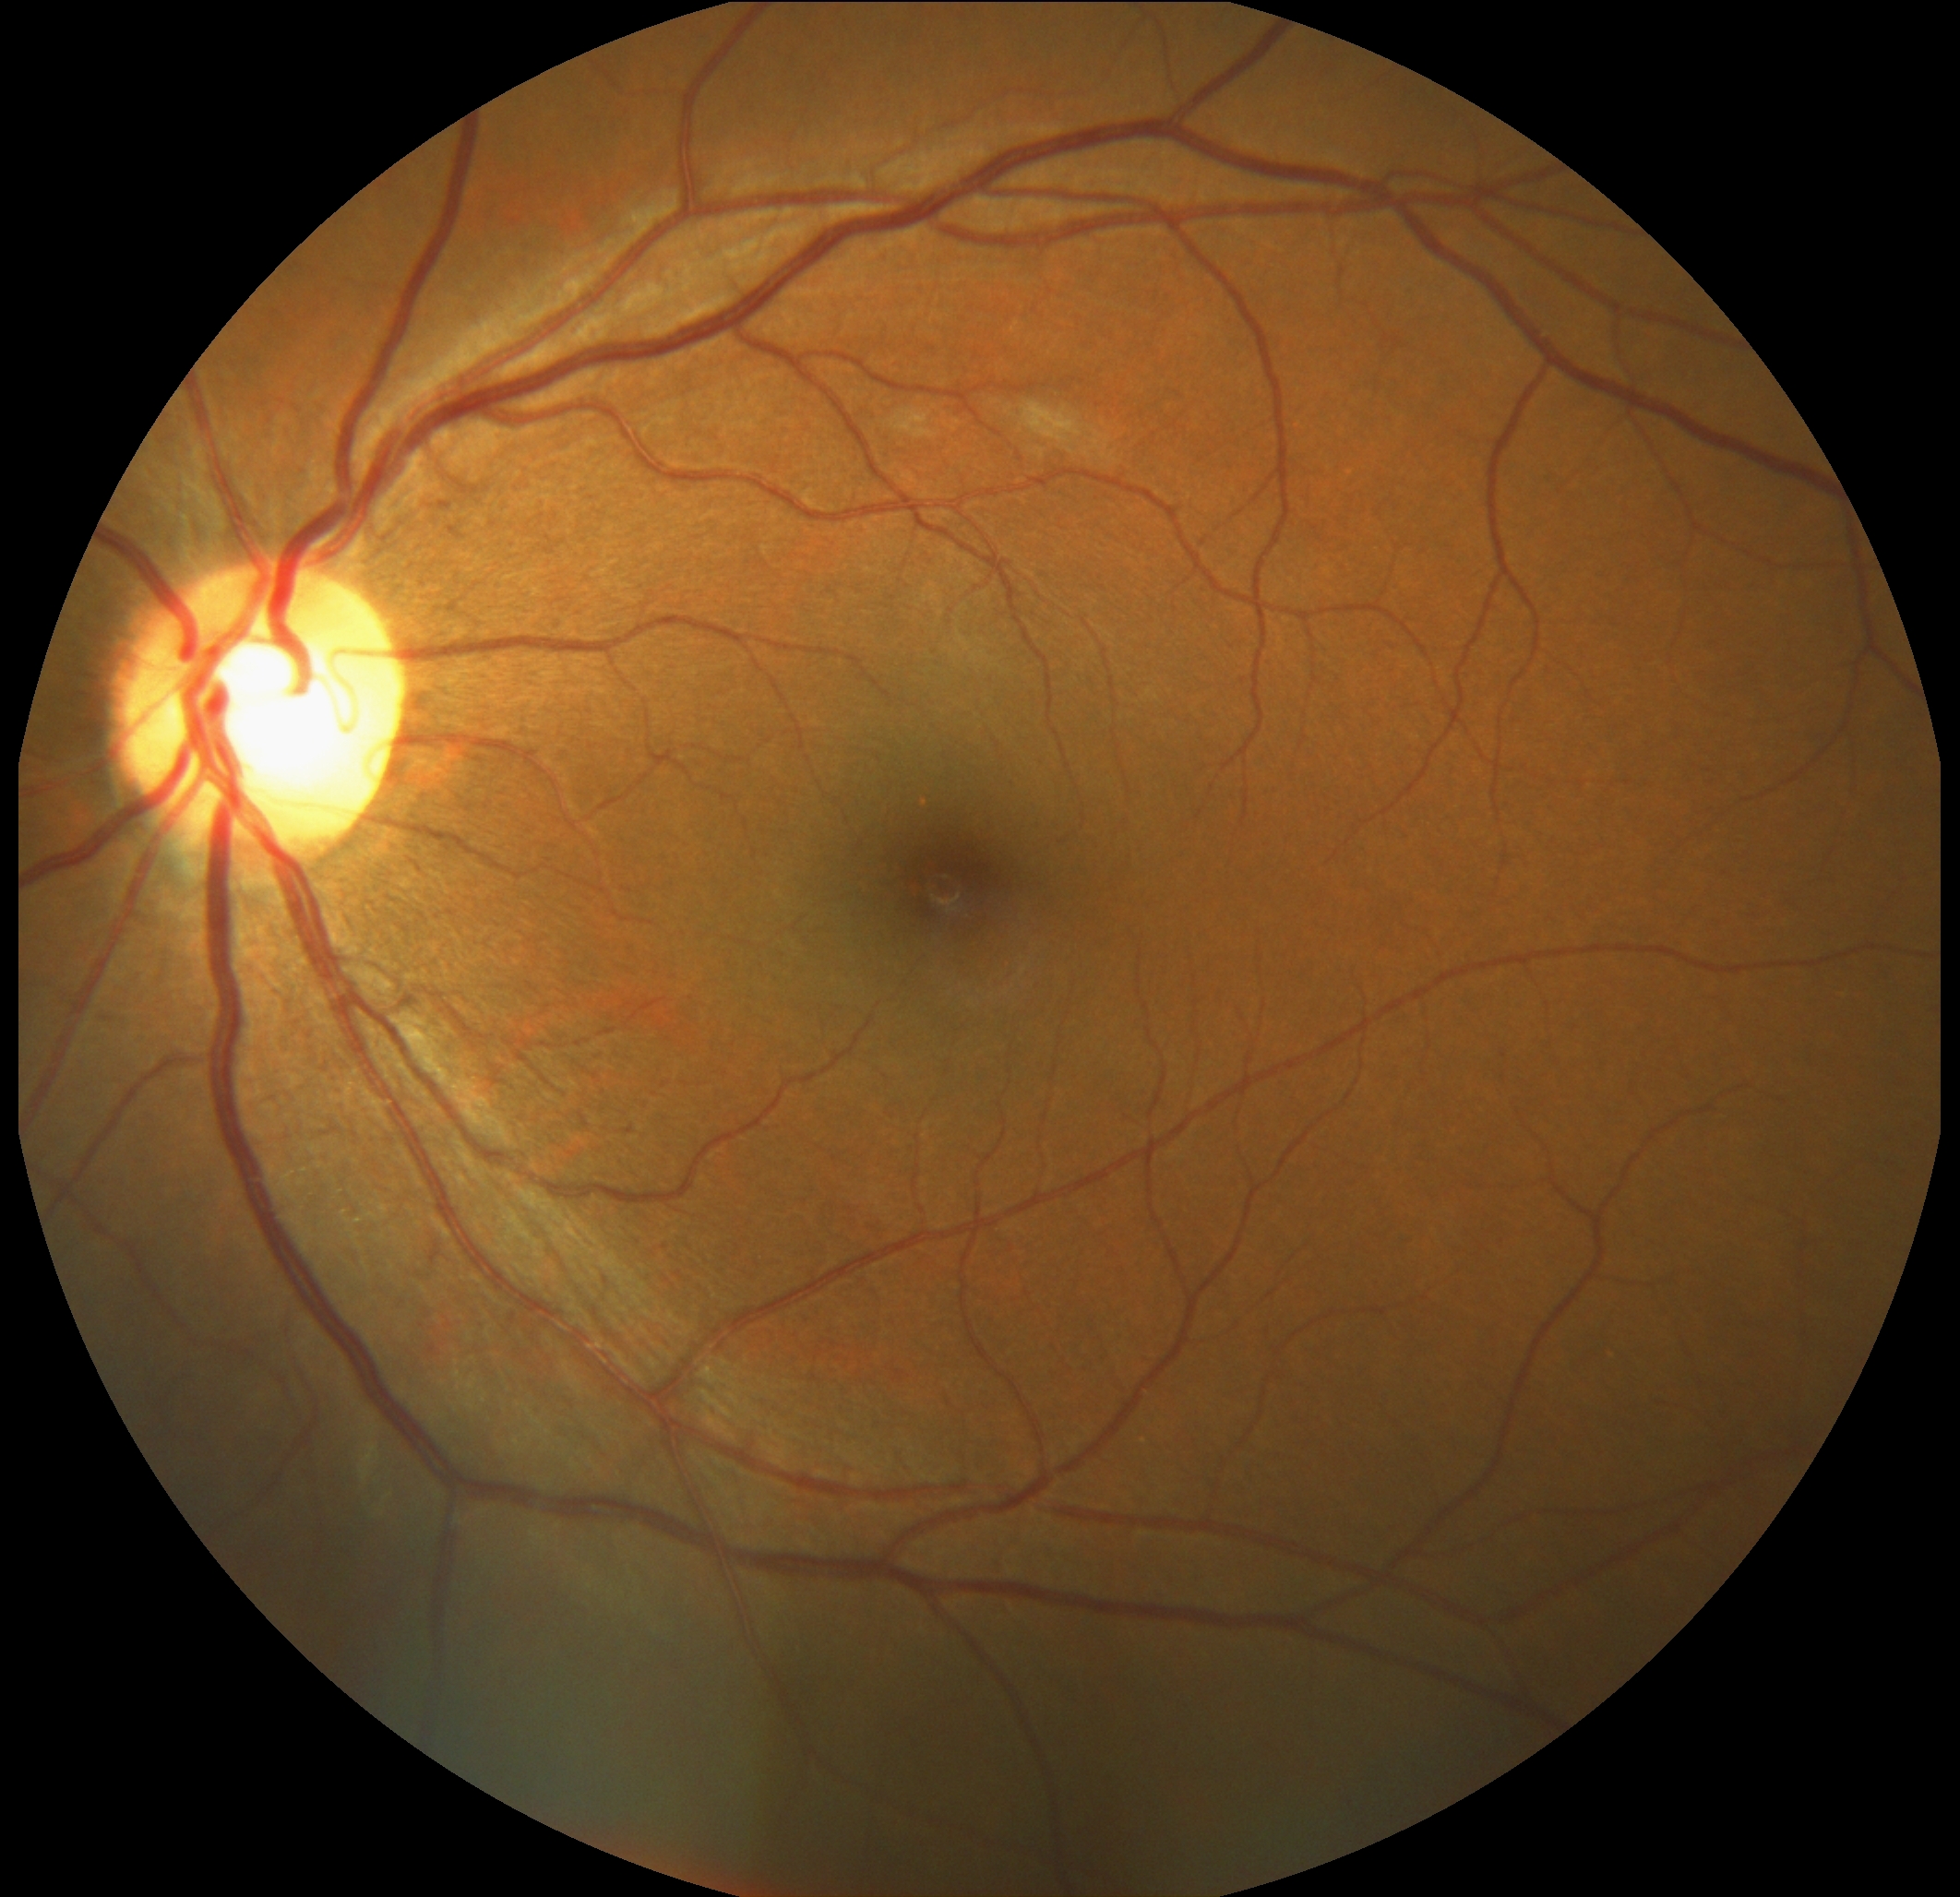
diabetic retinopathy severity=grade 2.